Acquired with a NIDEK AFC-230. Diabetic retinopathy graded by the modified Davis classification. Color fundus photograph.
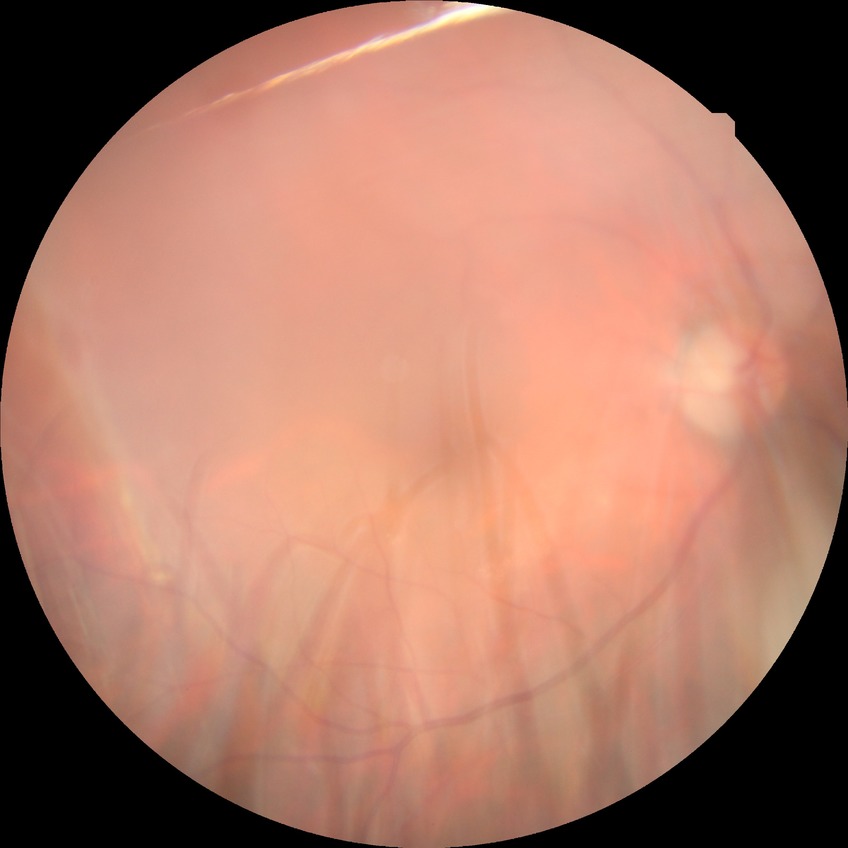

Diabetic retinopathy (DR): no diabetic retinopathy (NDR).